Image size 848x848 · diabetic retinopathy graded by the modified Davis classification · without pupil dilation · 45 degree fundus photograph · color fundus image · NIDEK AFC-230 fundus camera — 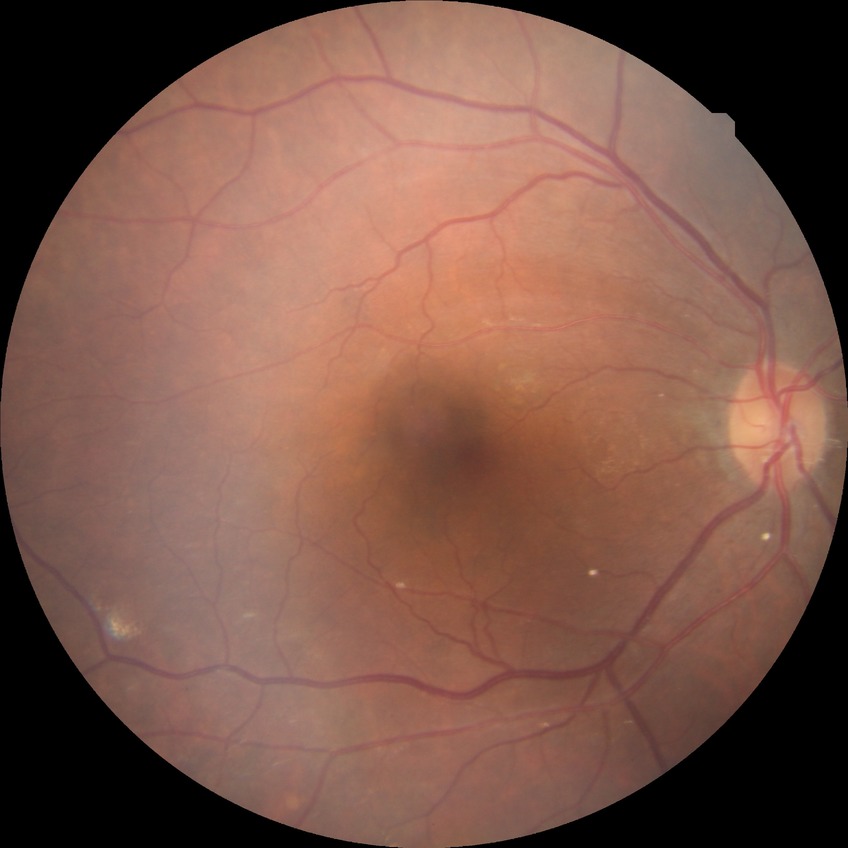

Modified Davis classification: simple diabetic retinopathy.